45° FOV:
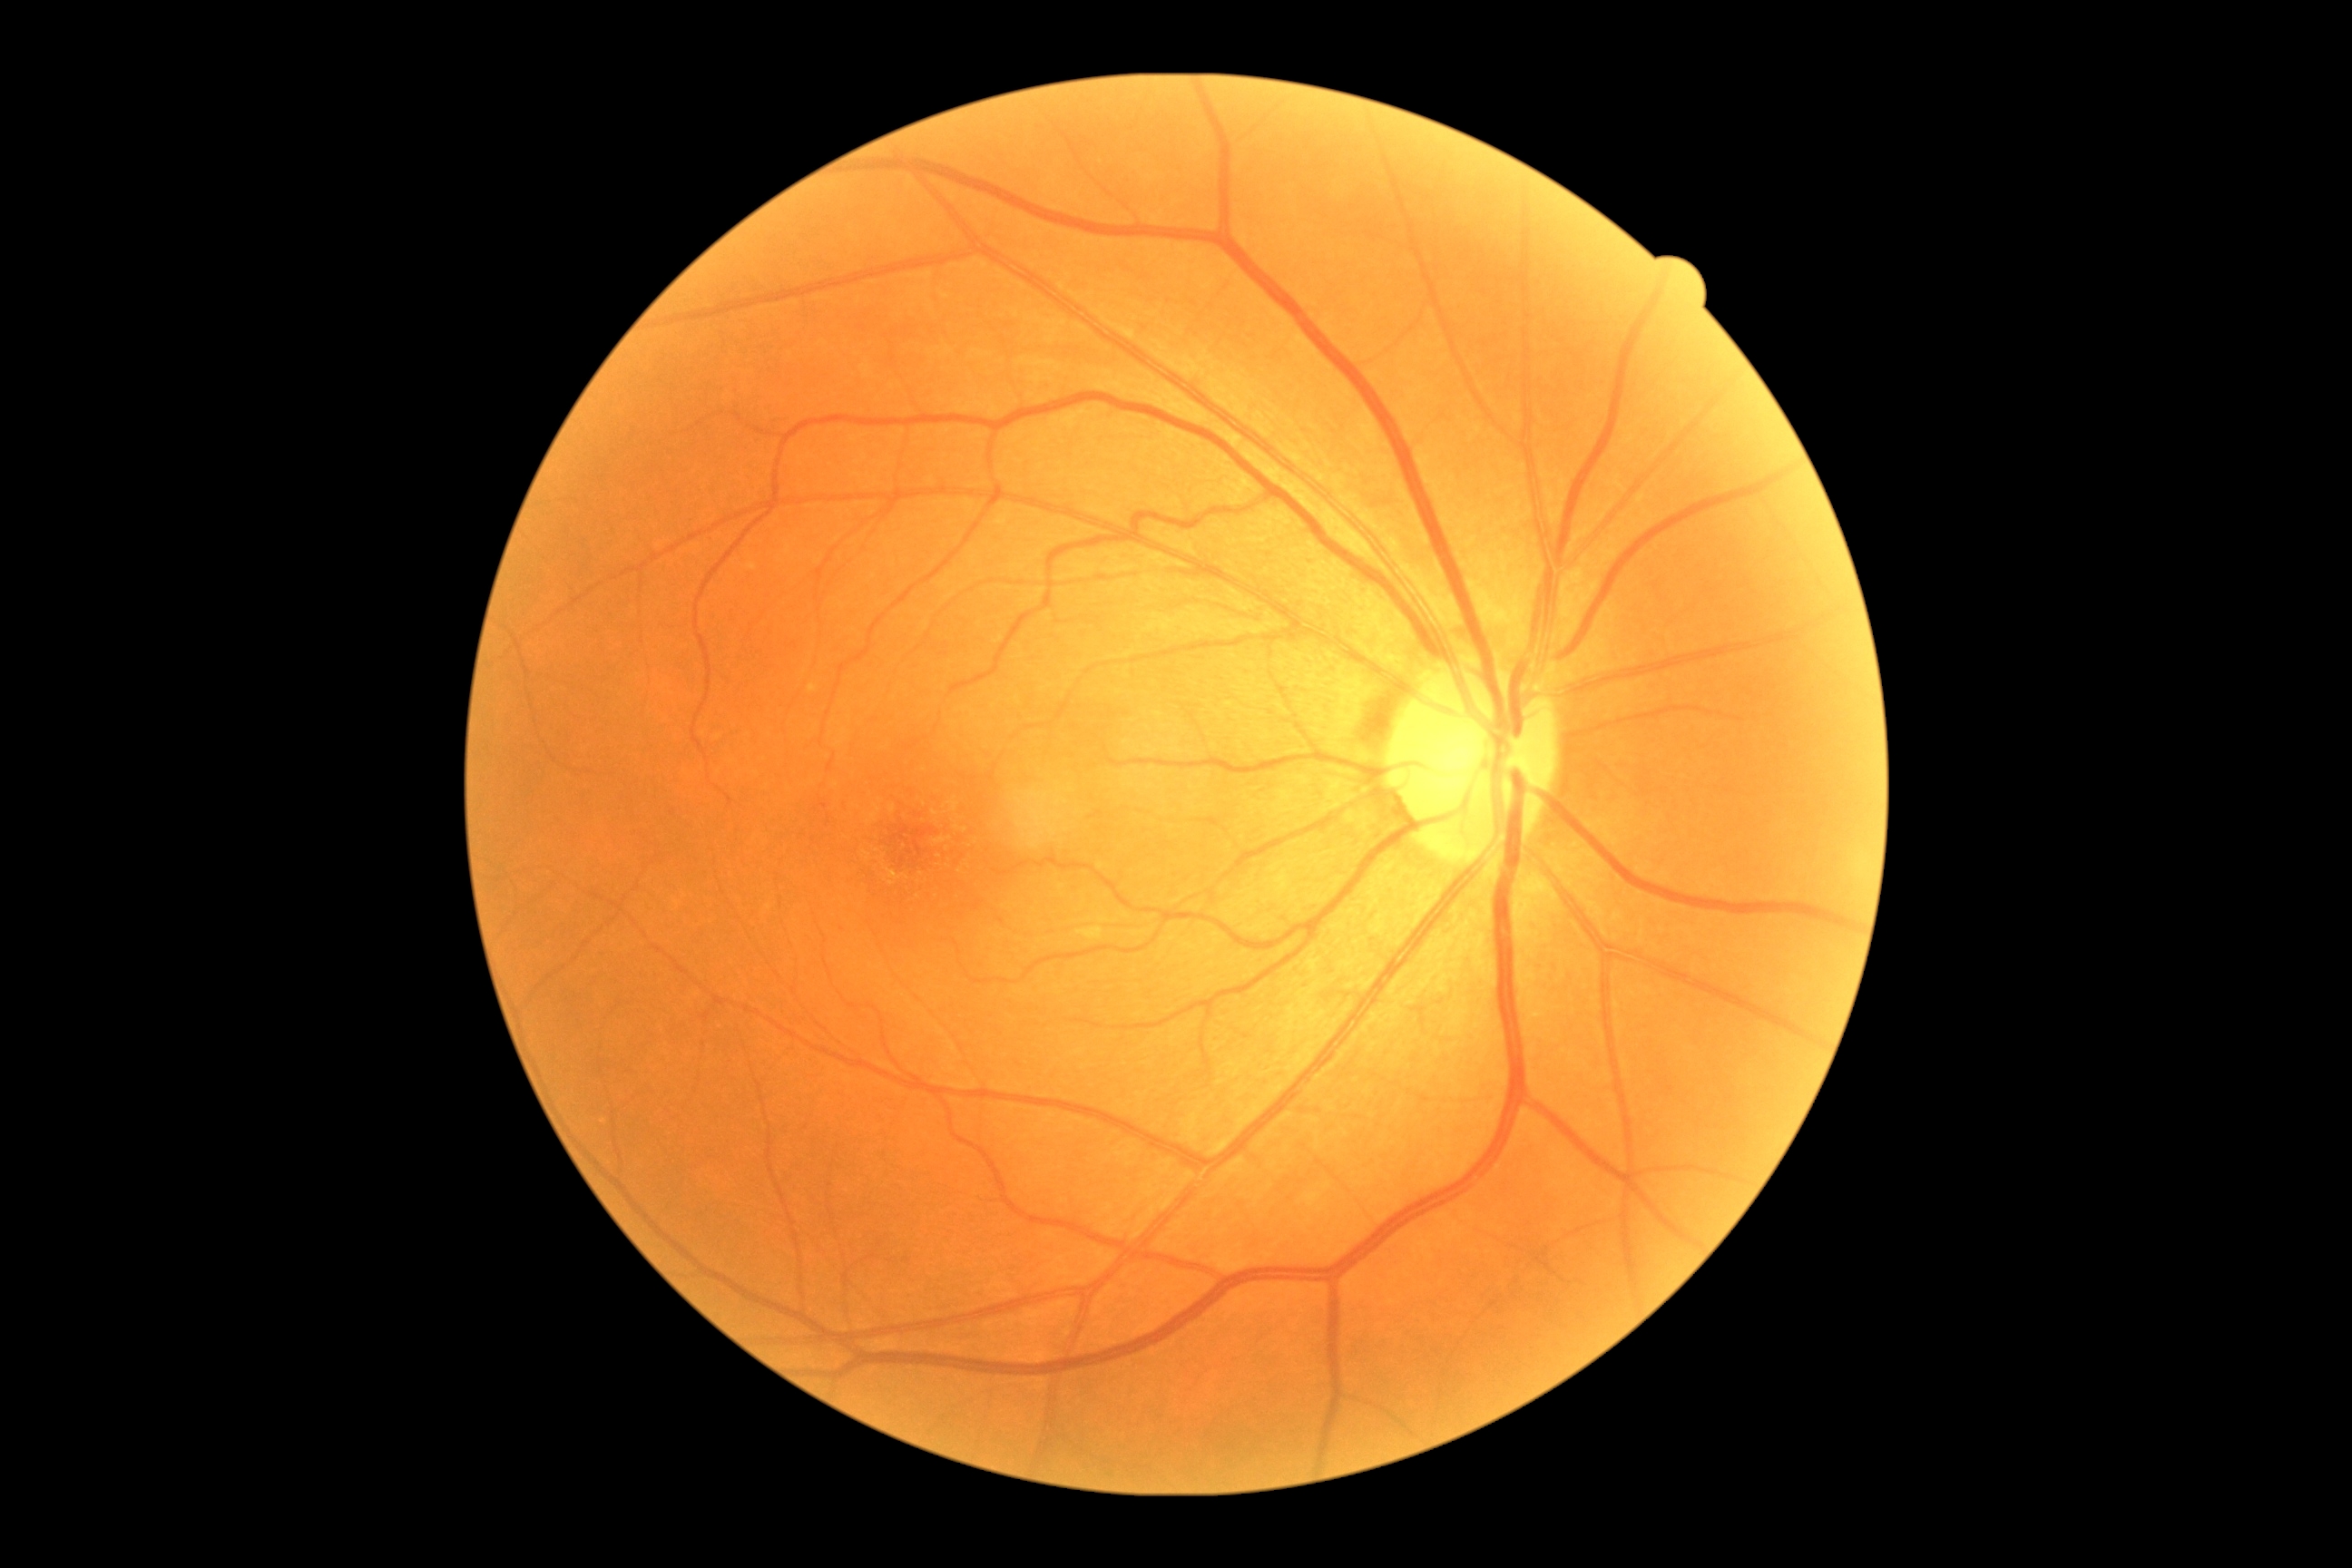
DR stage: grade 0 (no apparent retinopathy) — no visible signs of diabetic retinopathy.